Wide-field fundus photograph from neonatal ROP screening: 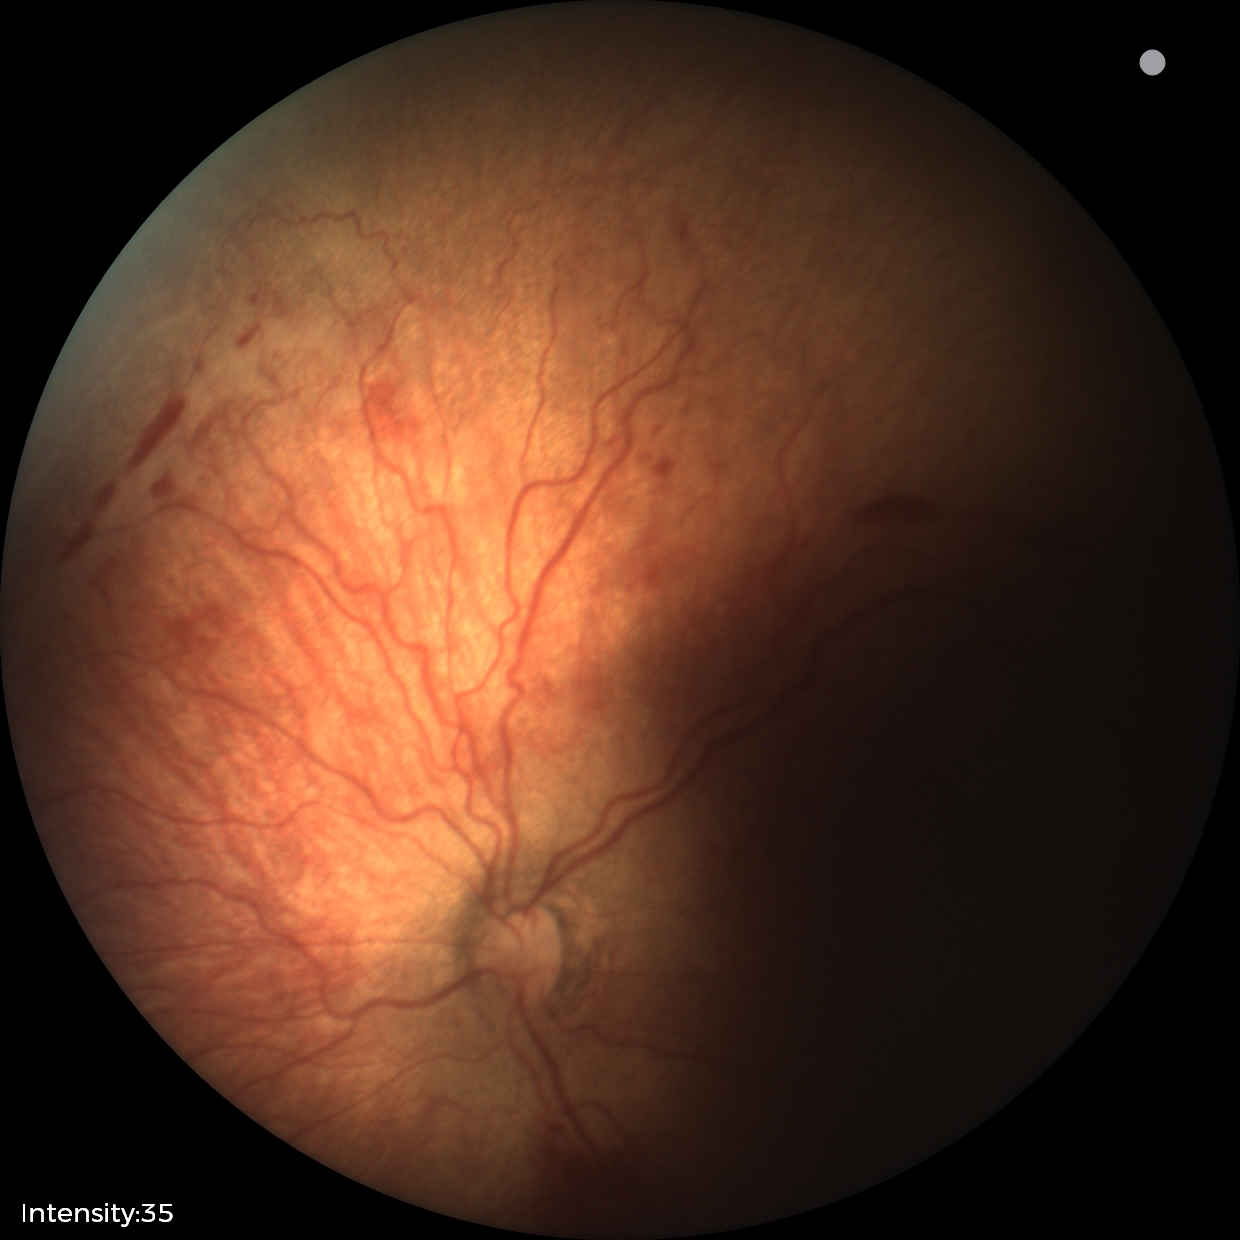 Screening series with ROP stage 2.